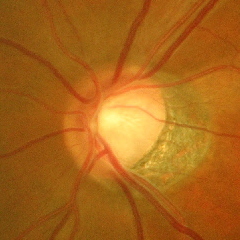

Q: Is glaucoma present?
A: Yes — advanced glaucoma.